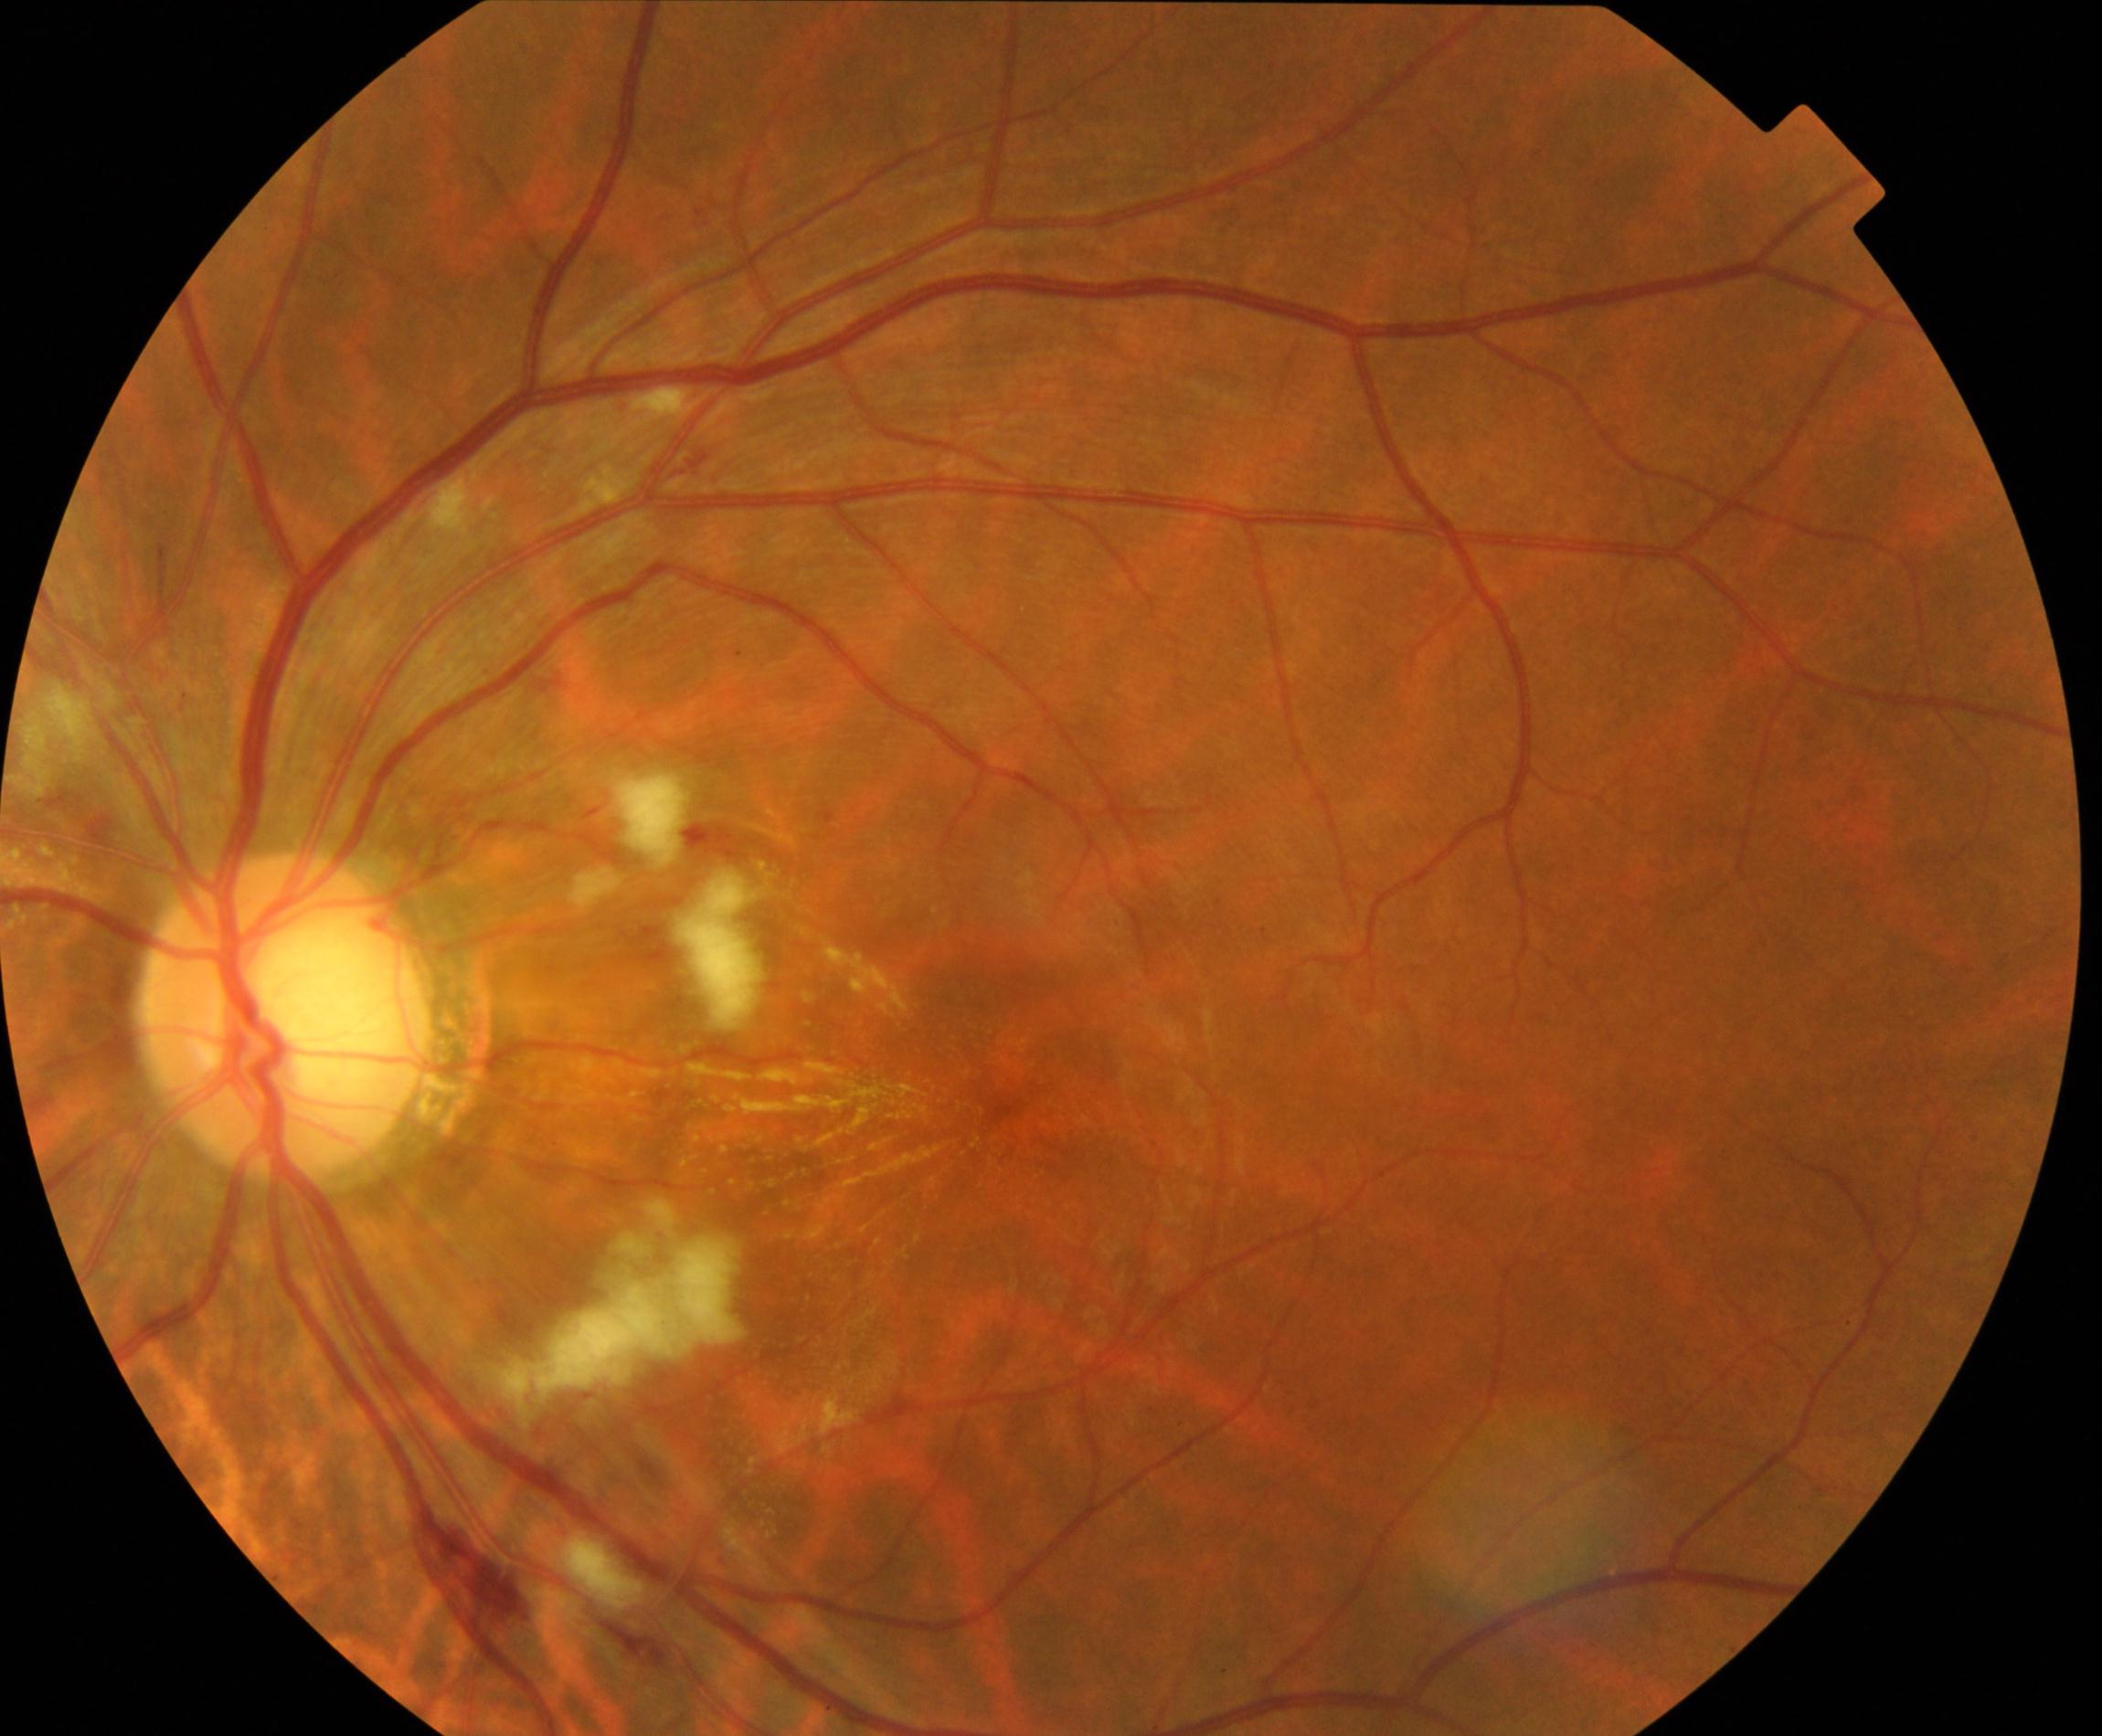
This fundus photograph shows cotton-wool spots.